130° field of view (Natus RetCam Envision); wide-field fundus image from infant ROP screening; 1440x1080px: 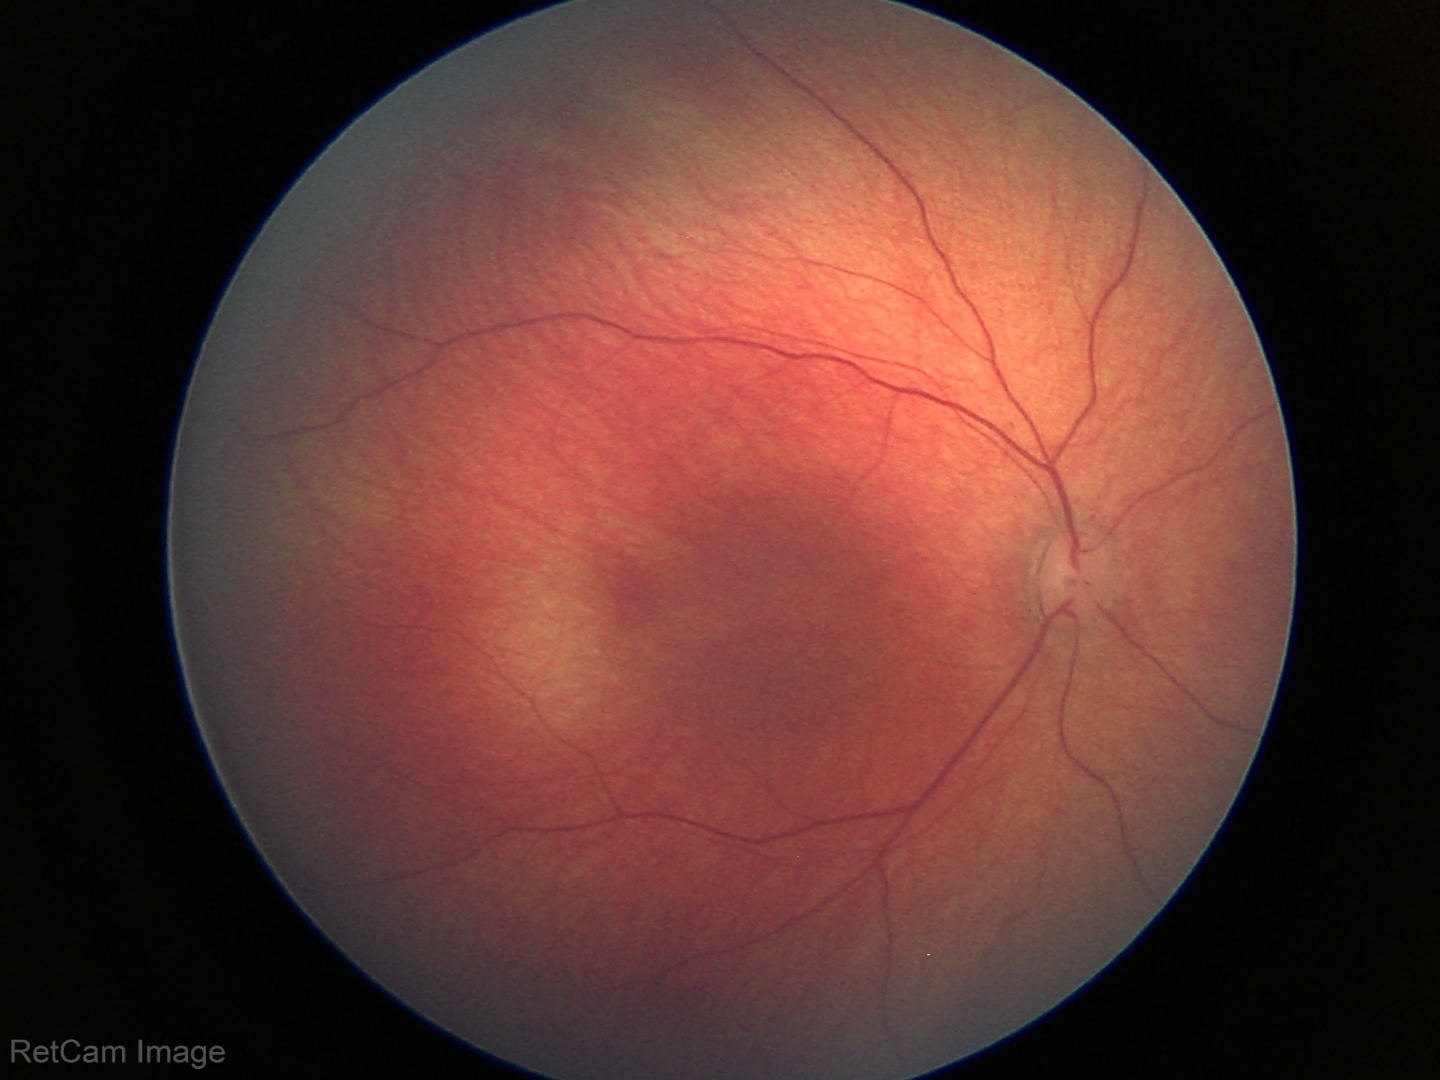 Assessment: no abnormal retinal findings.